Modified Davis grading:
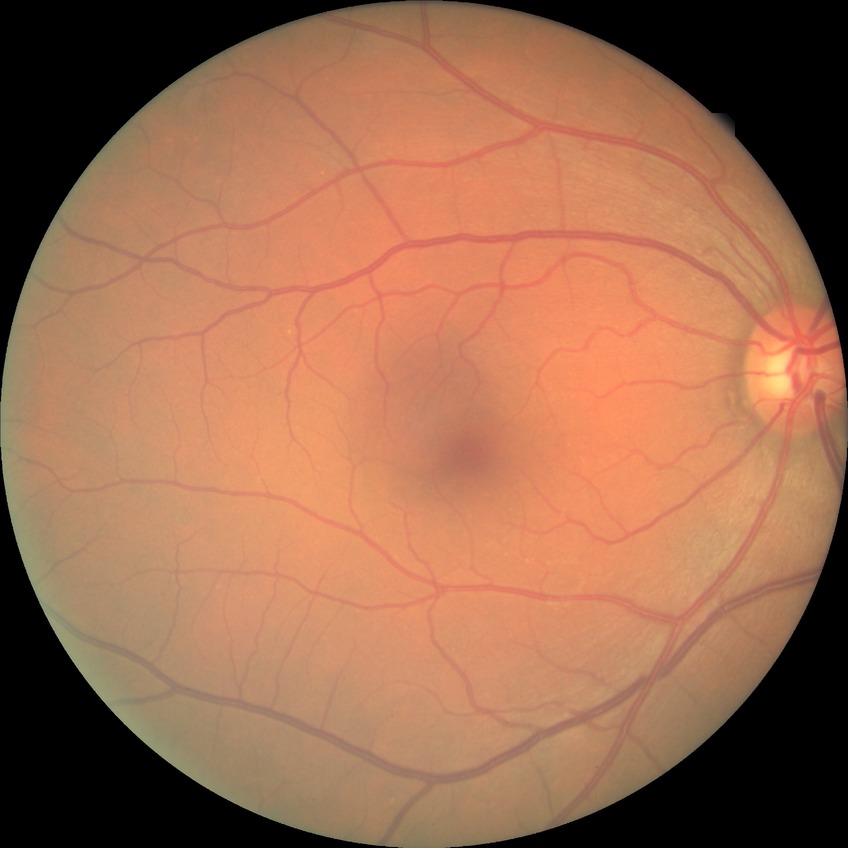

Diabetic retinopathy (DR) is NDR (no diabetic retinopathy).